Retinal fundus photograph. 45° field of view.
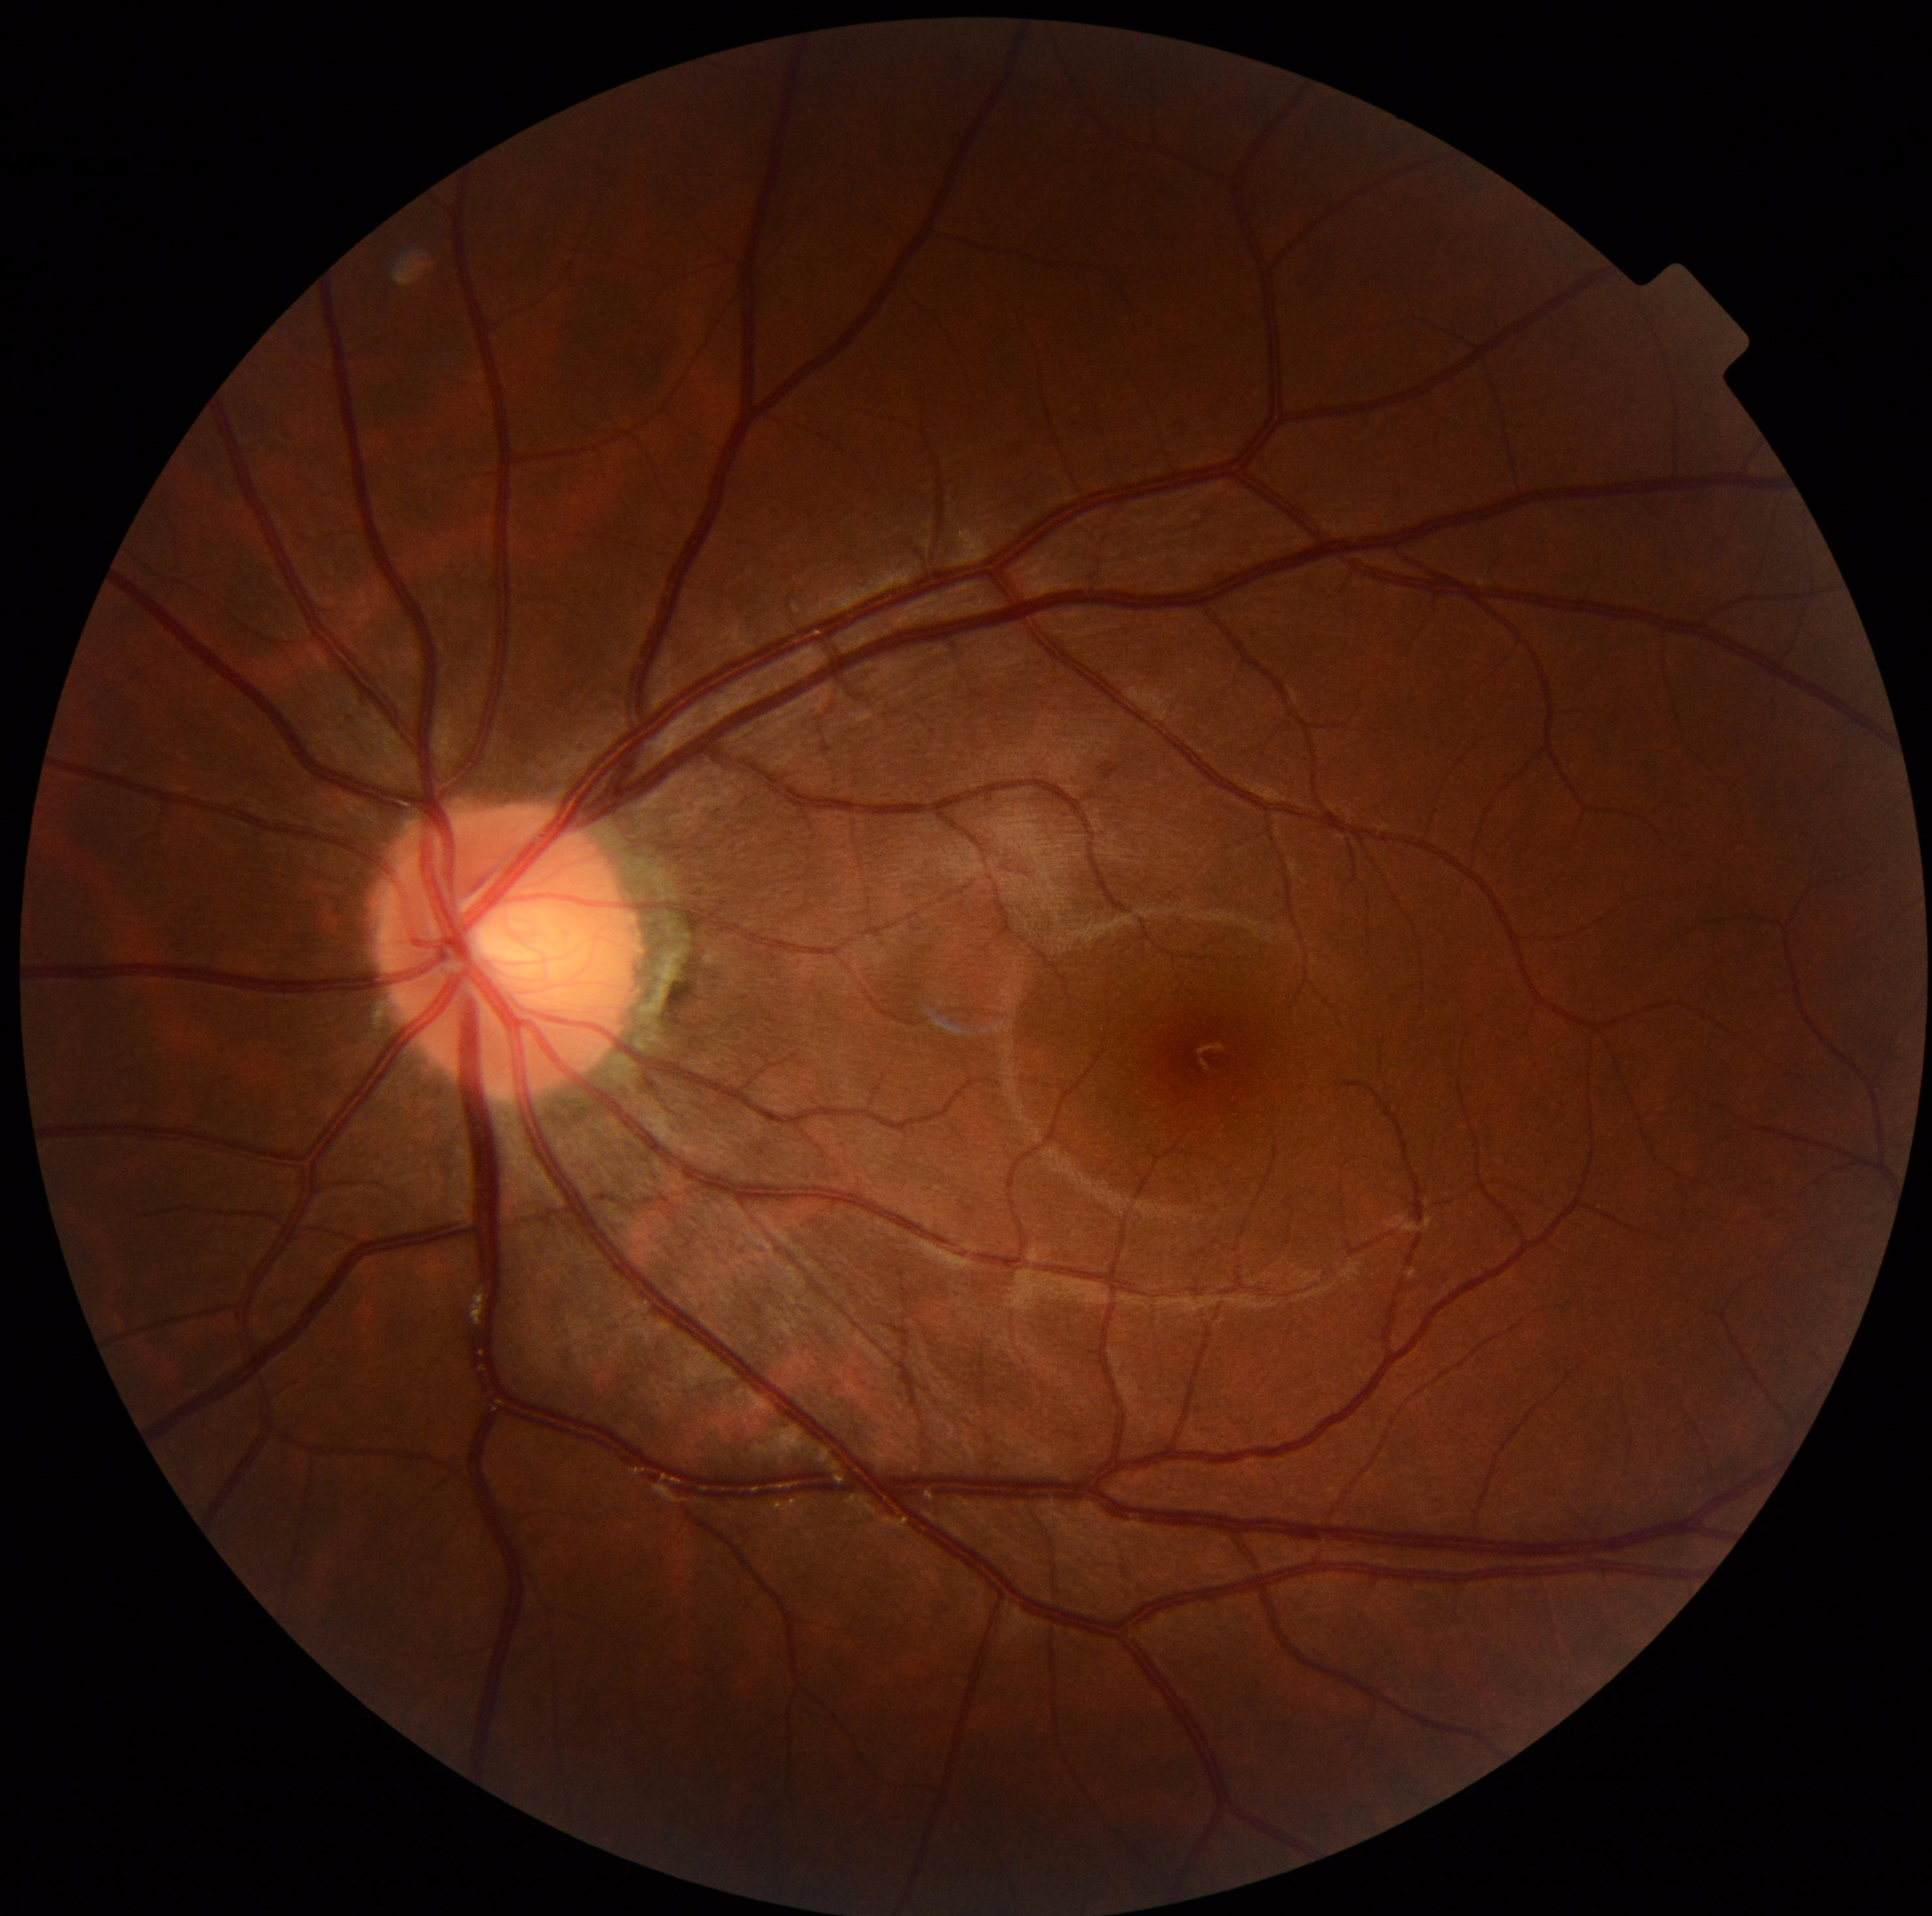
DR: grade 0 (no apparent retinopathy) — no visible signs of diabetic retinopathy.